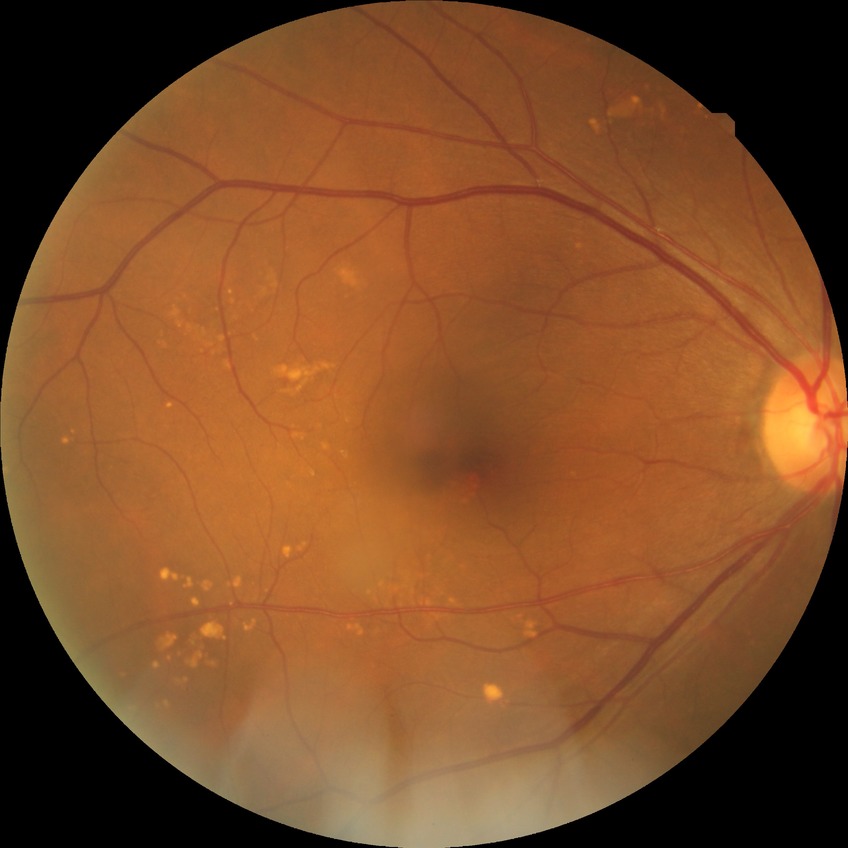 Diabetic retinopathy (DR) is NDR (no diabetic retinopathy).